1624 x 1232 pixels: 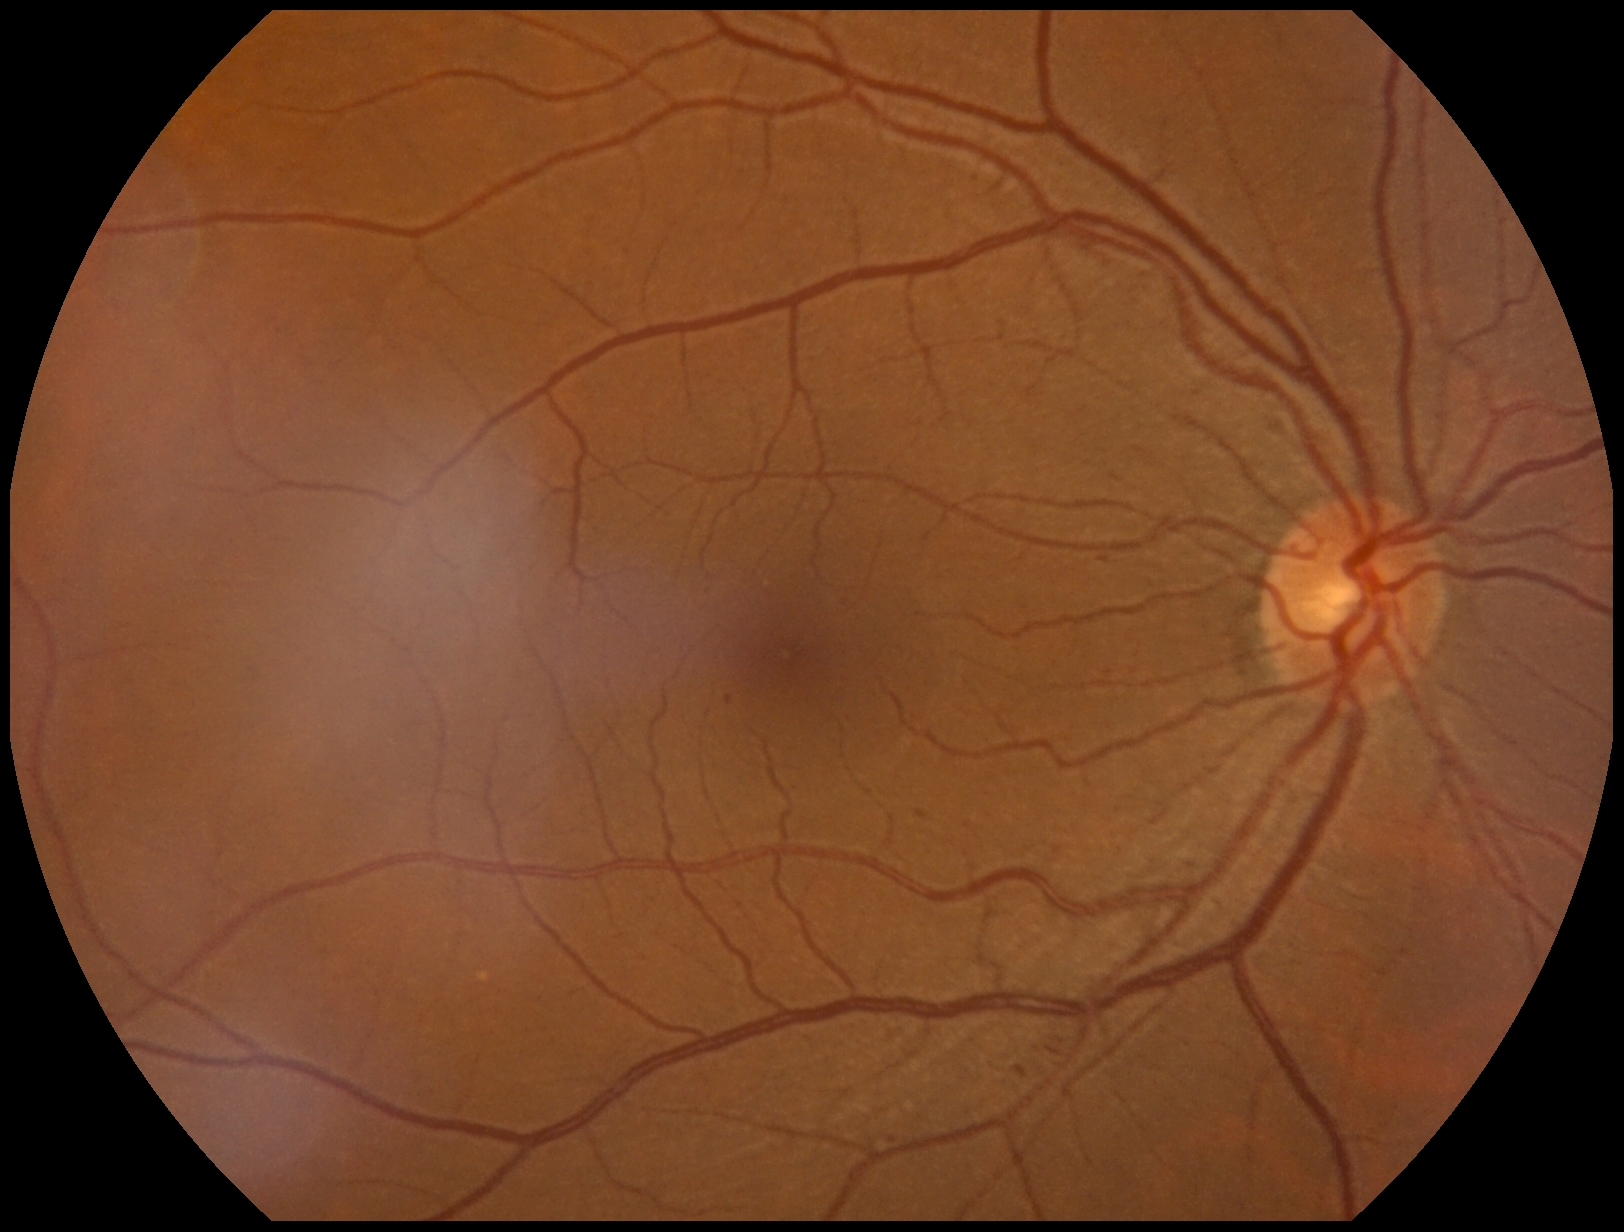

Diabetic retinopathy grade: 2.
The retinopathy is classified as non-proliferative diabetic retinopathy.